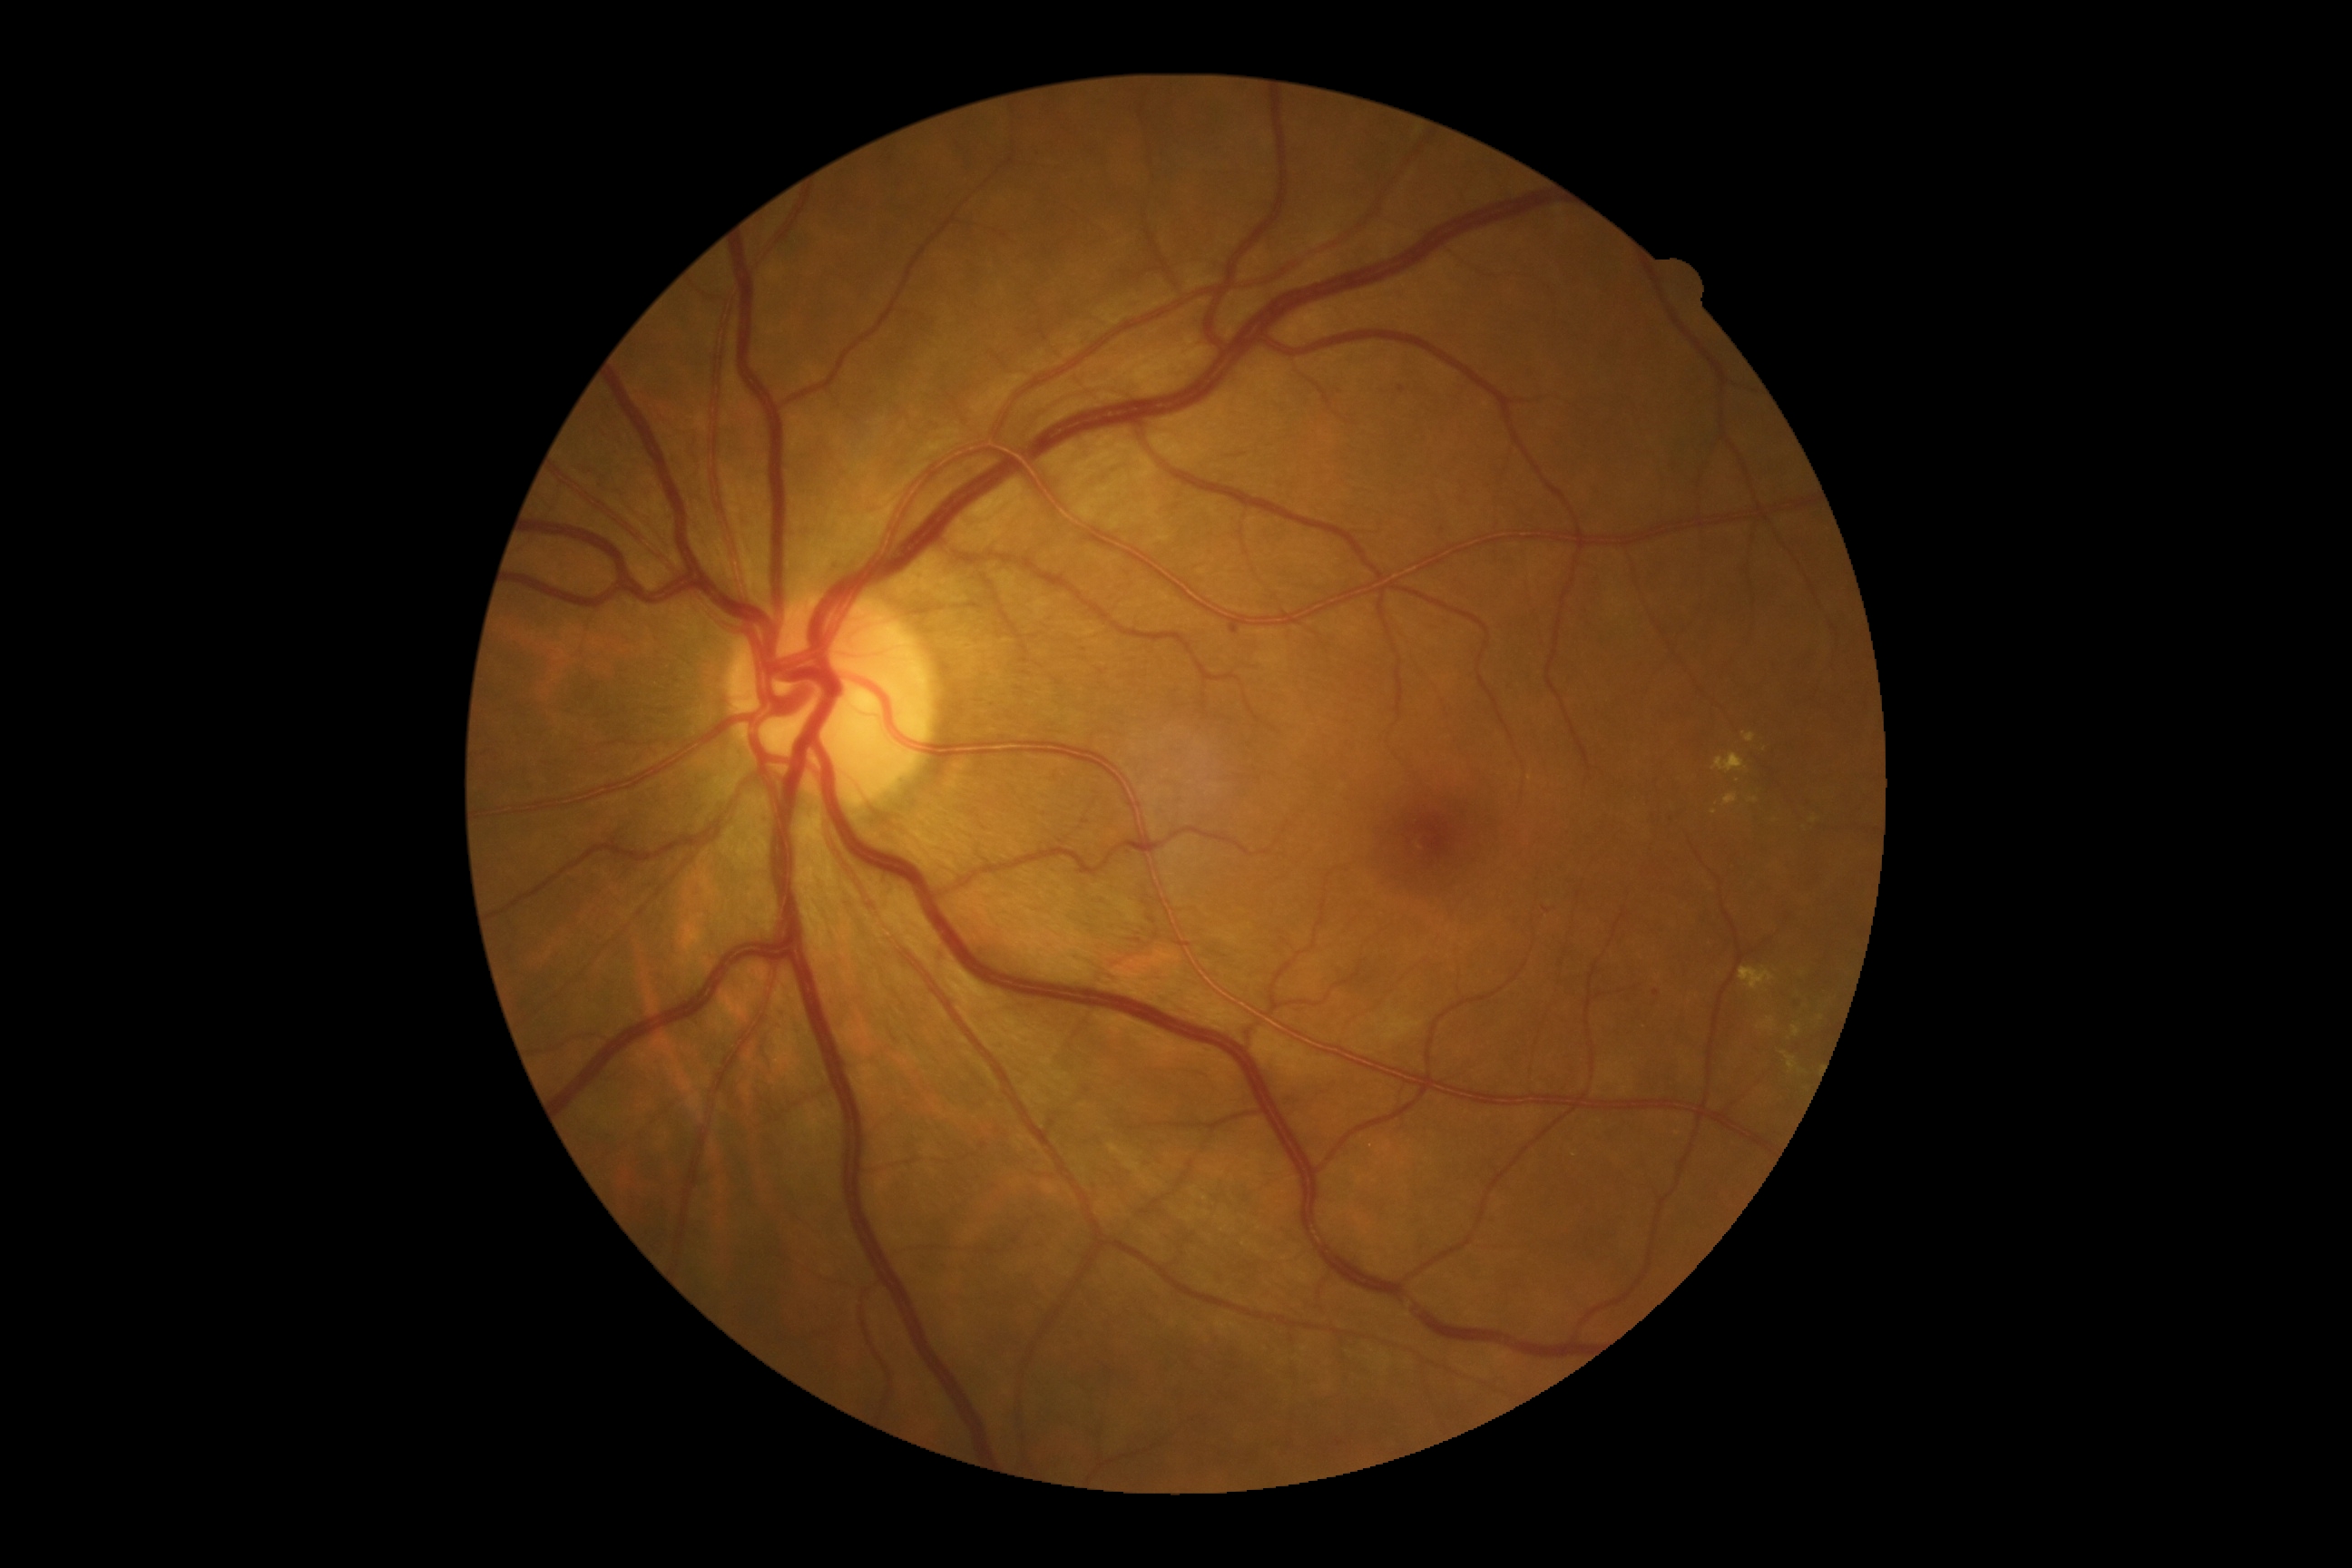 DR: 2/4.